Pediatric retinal photograph (wide-field); 1240x1240 — 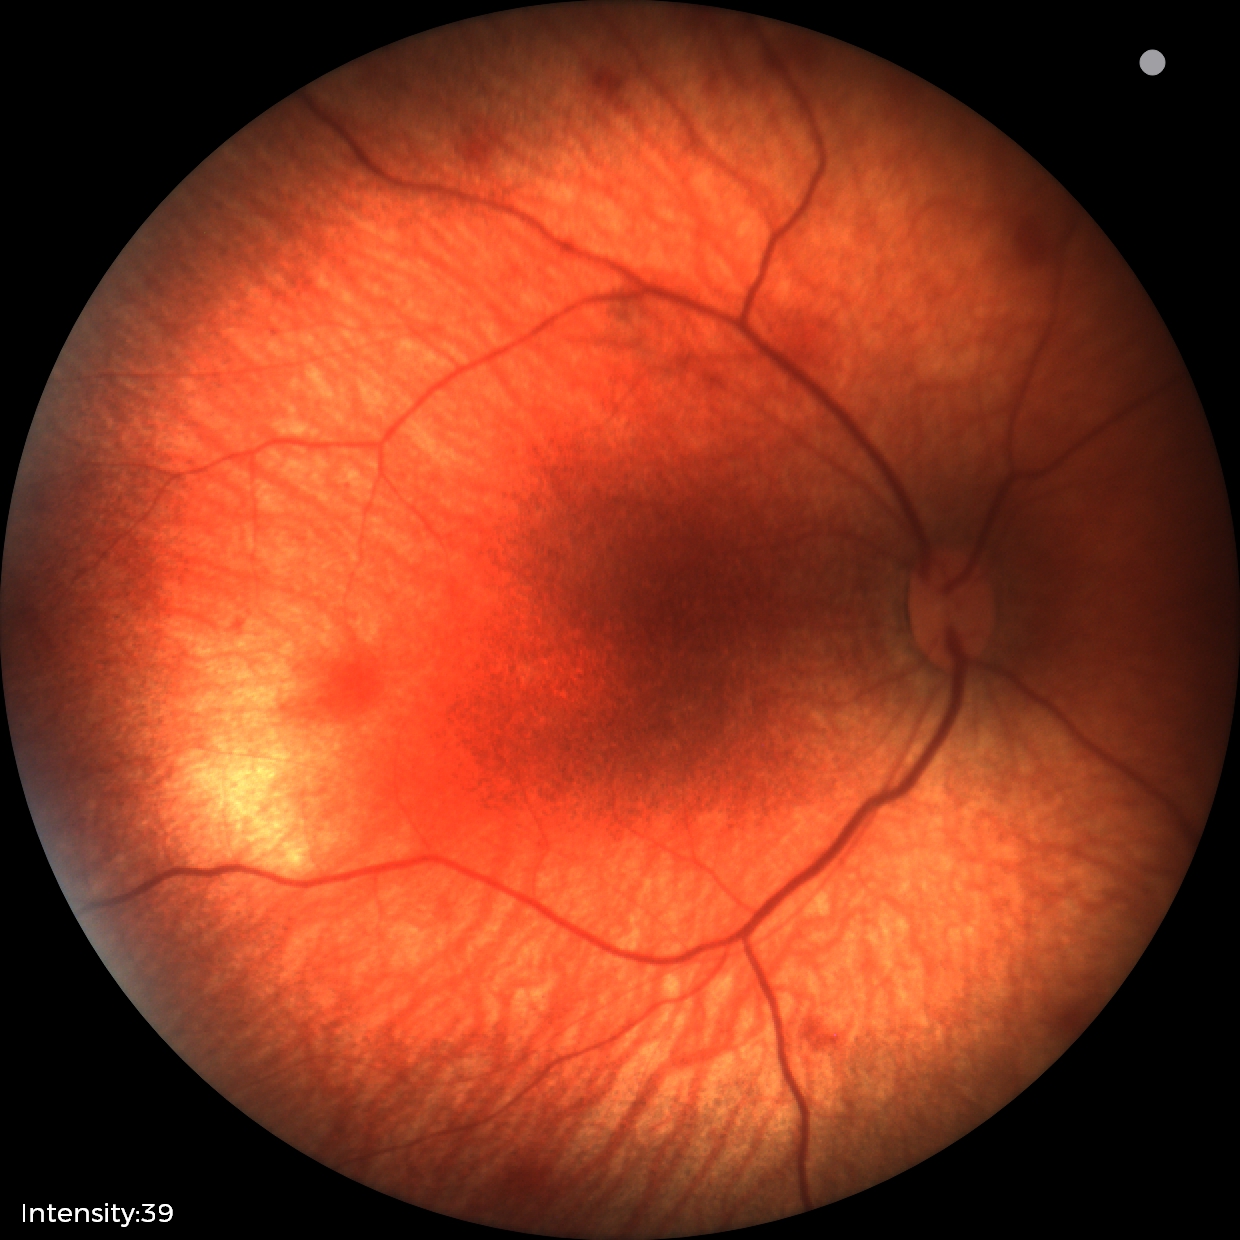

Screening examination consistent with retinal hemorrhages.